Fundus photo · 2212x1659px:
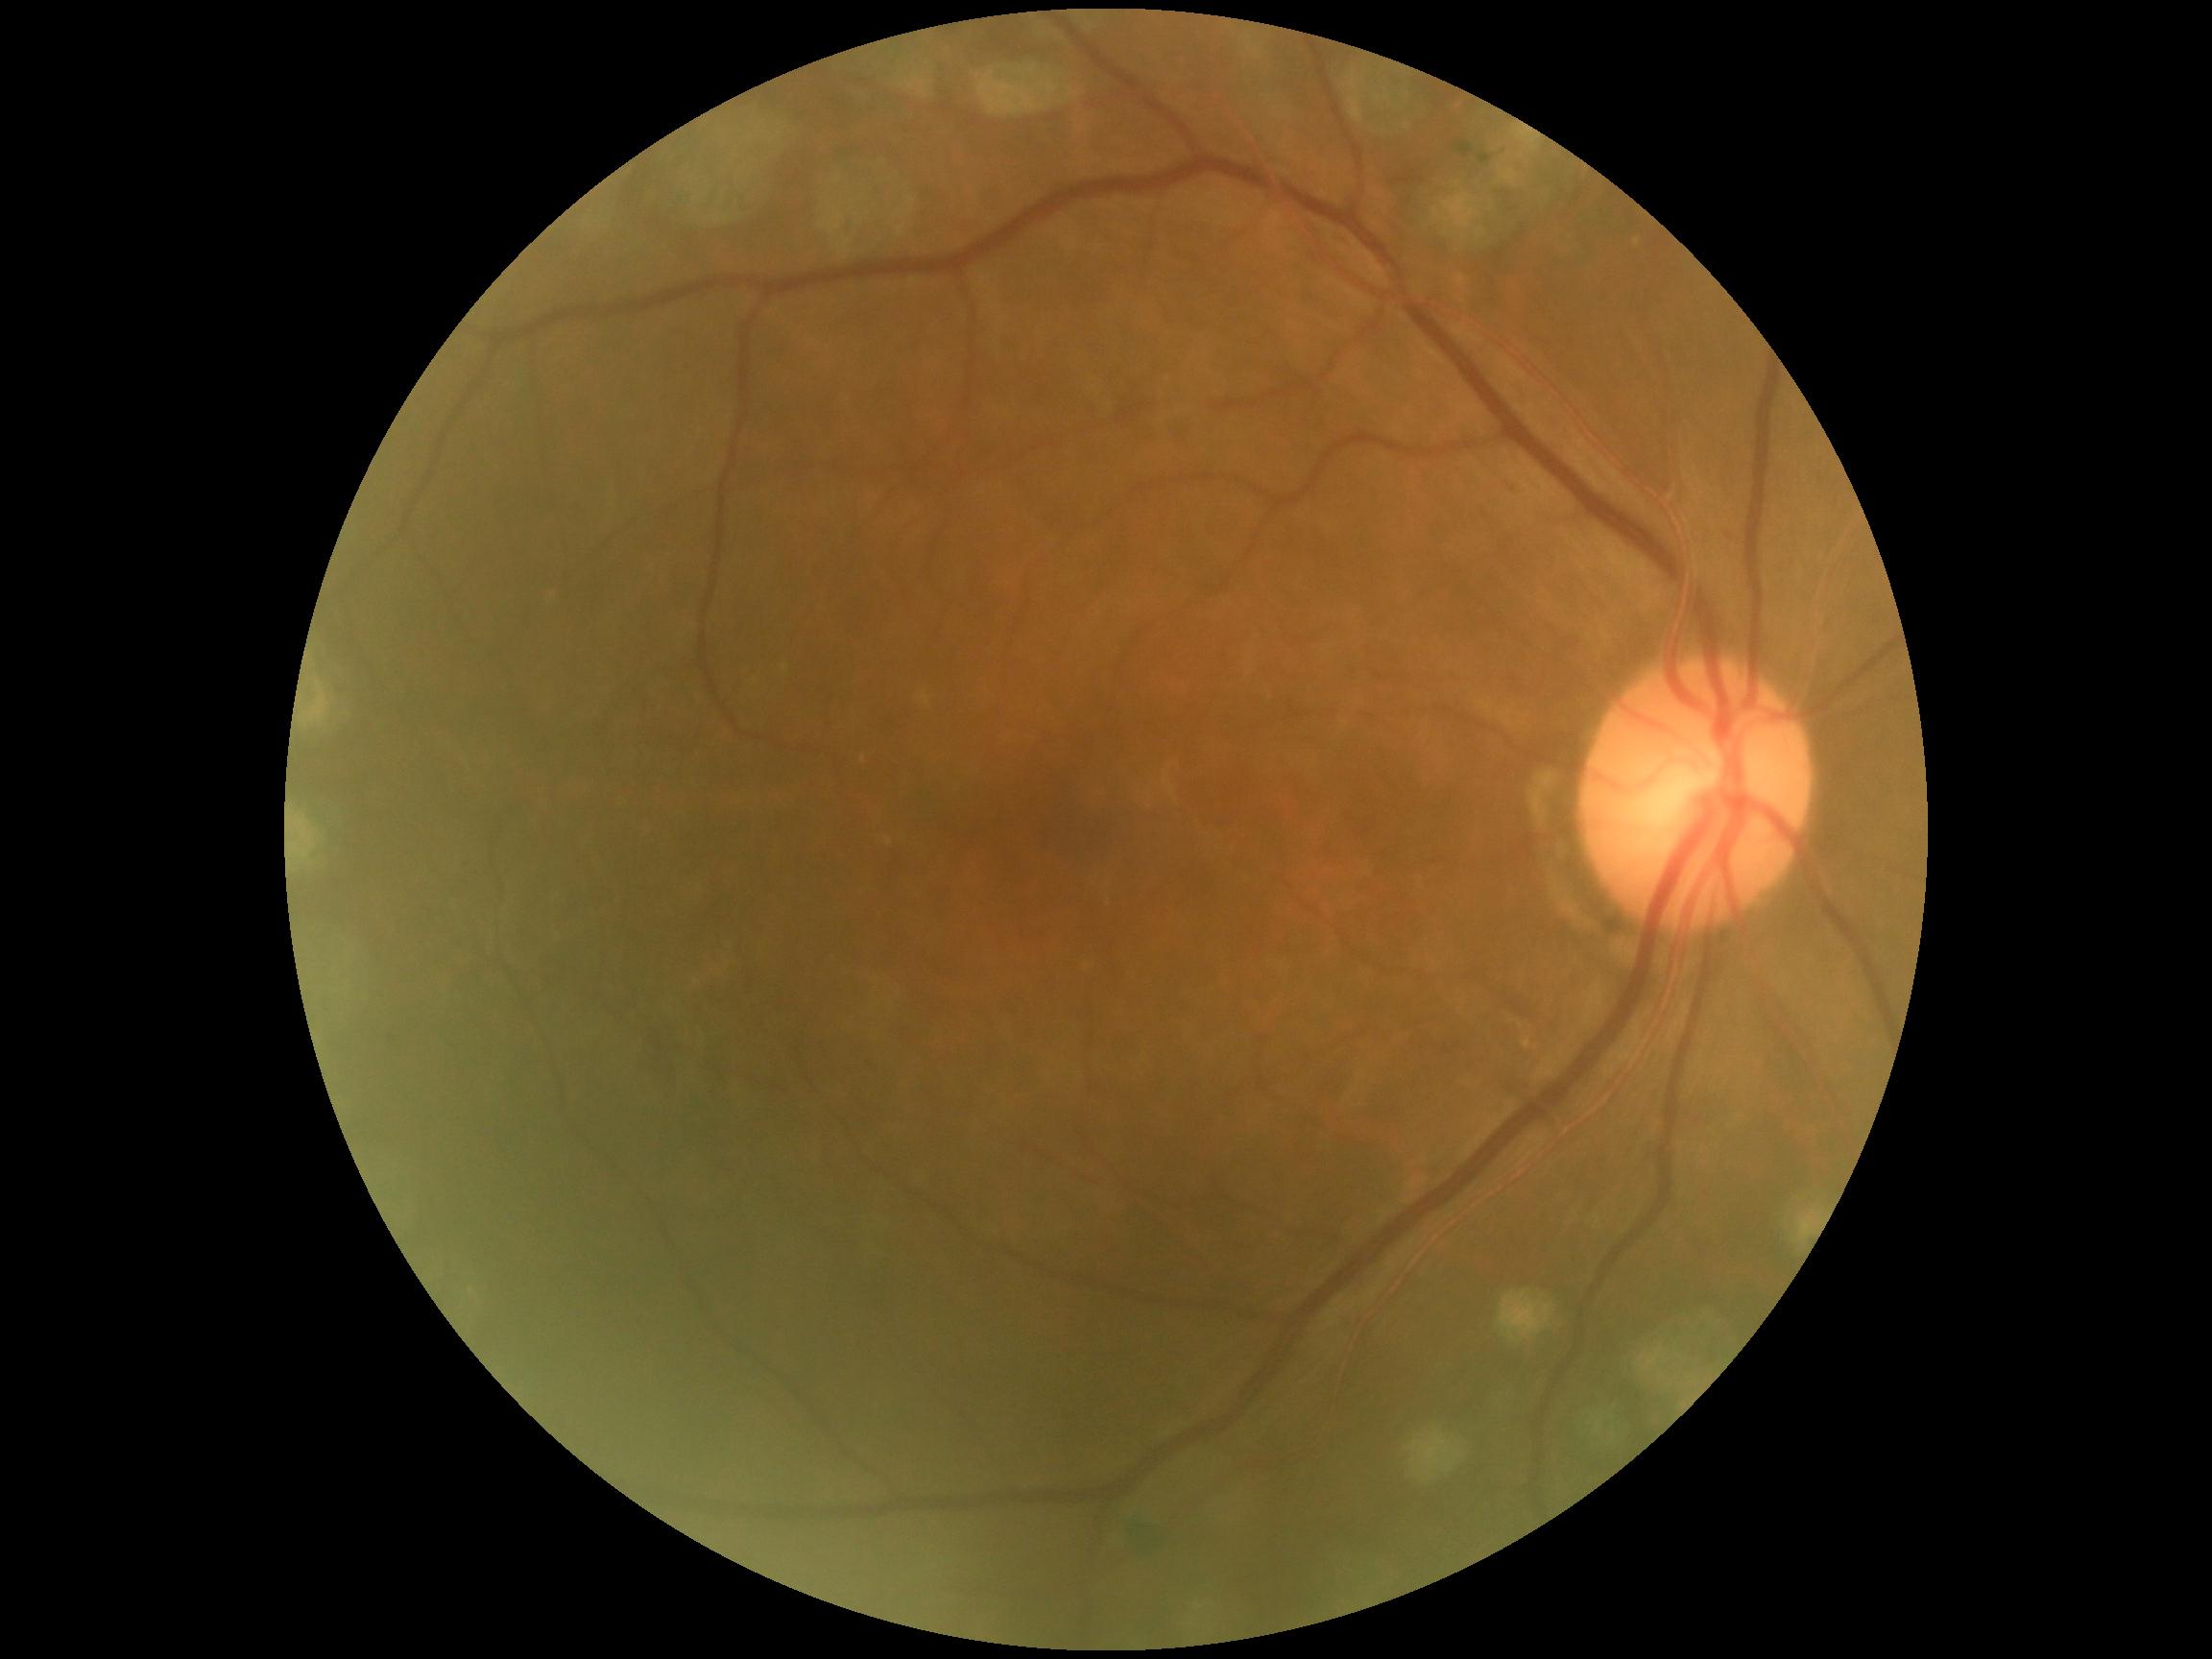
Findings:
– DR impression: negative for DR
– diabetic retinopathy (DR): grade 0 (no apparent retinopathy)